2048 by 1536 pixels. 45-degree field of view:
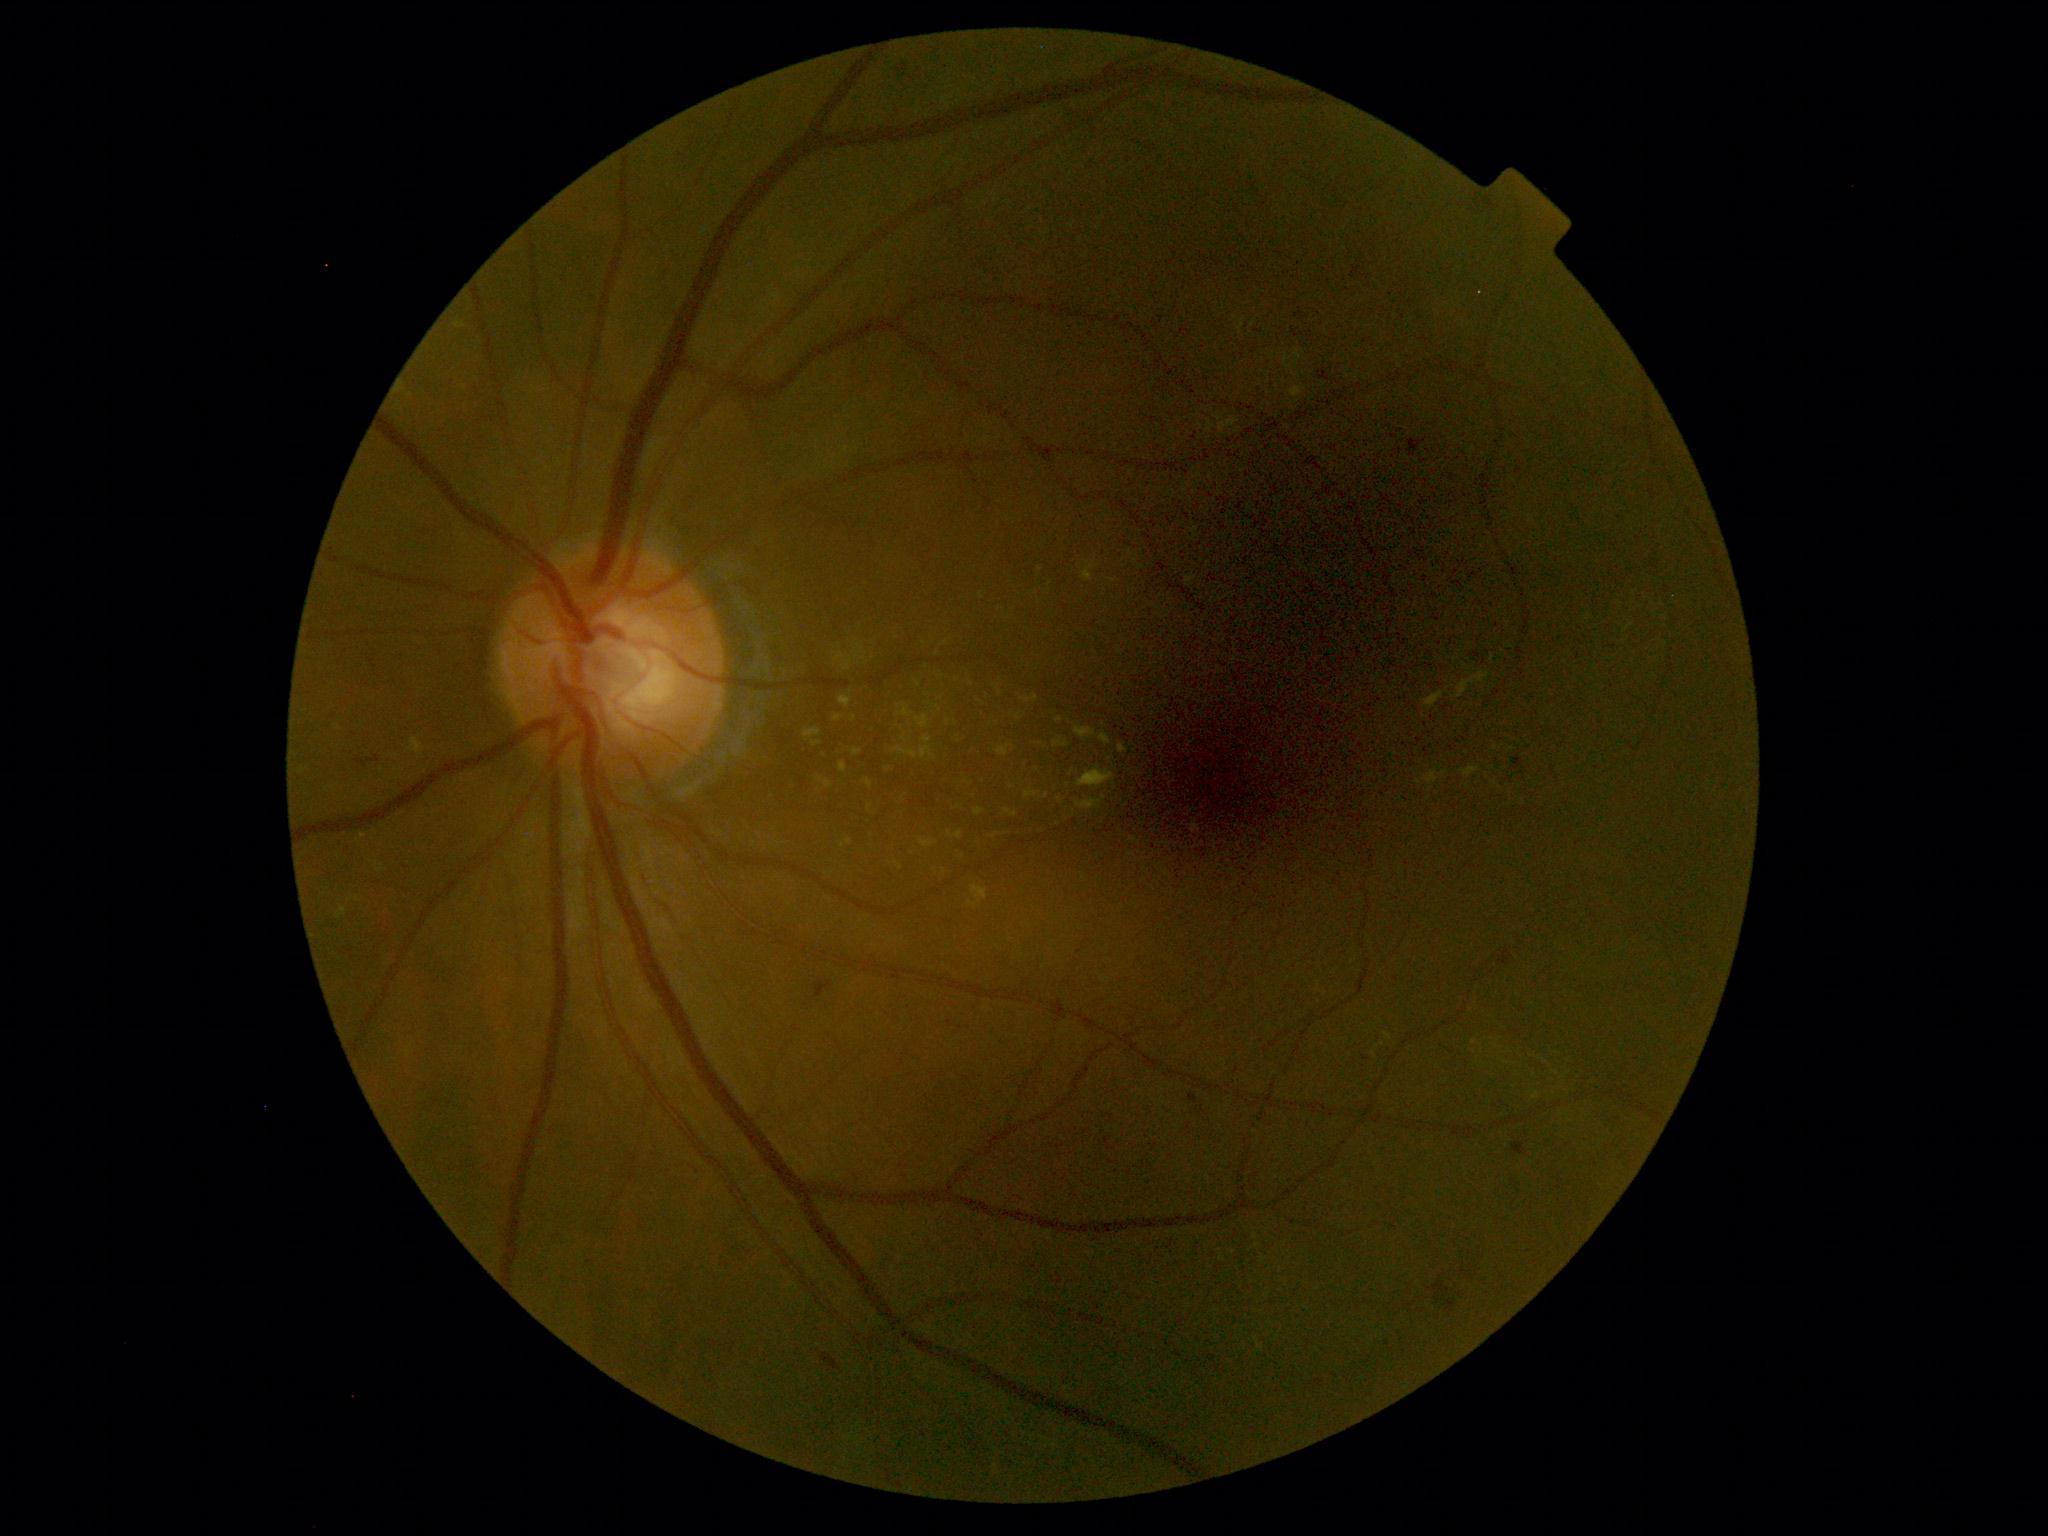
DR severity: moderate NPDR (grade 2).